NIDEK AFC-230 fundus camera · 45° field of view · nonmydriatic fundus photograph · 848x848px · DR severity per modified Davis staging.
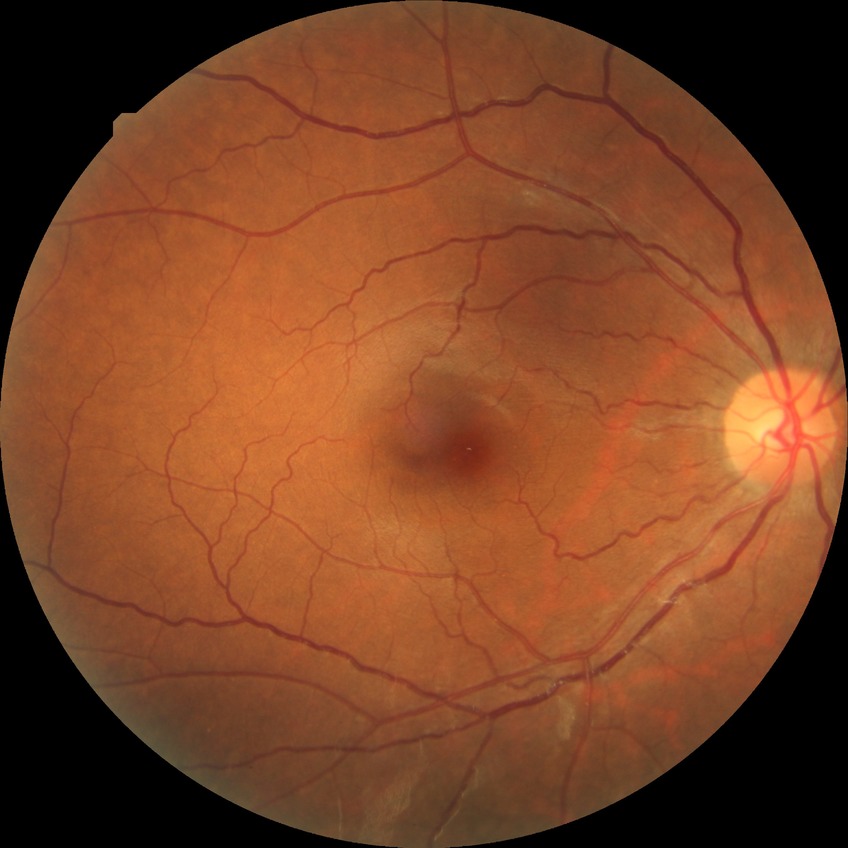

Diabetic retinopathy (DR) is no diabetic retinopathy (NDR).